848x848px, diabetic retinopathy graded by the modified Davis classification, 45-degree field of view, color fundus image:
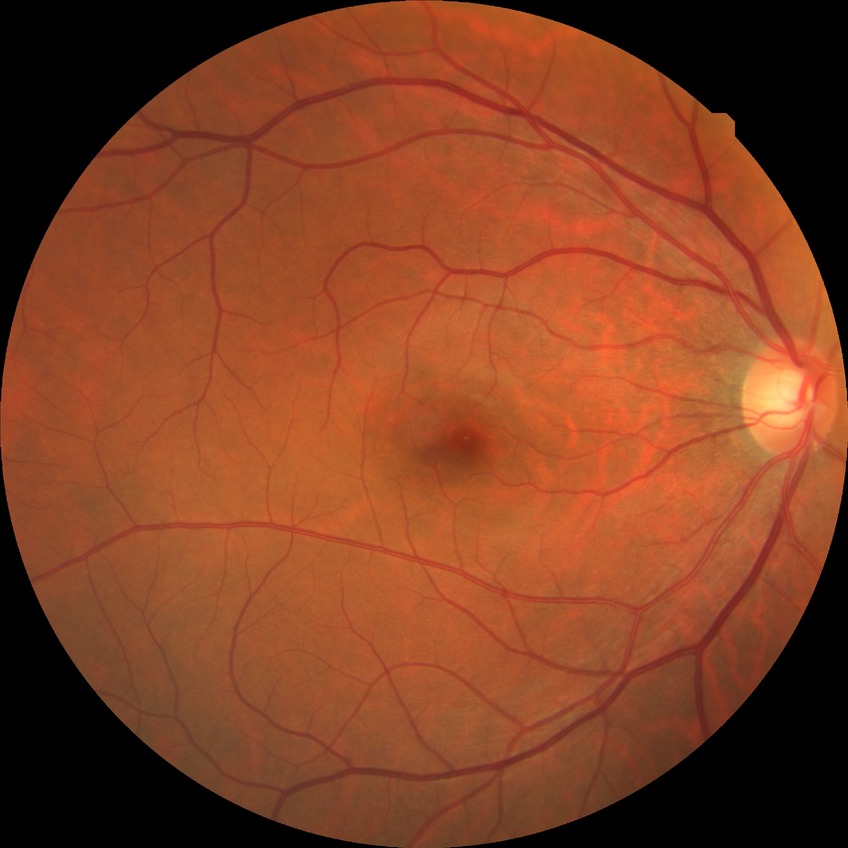
DR: NDR.